RetCam wide-field infant fundus image.
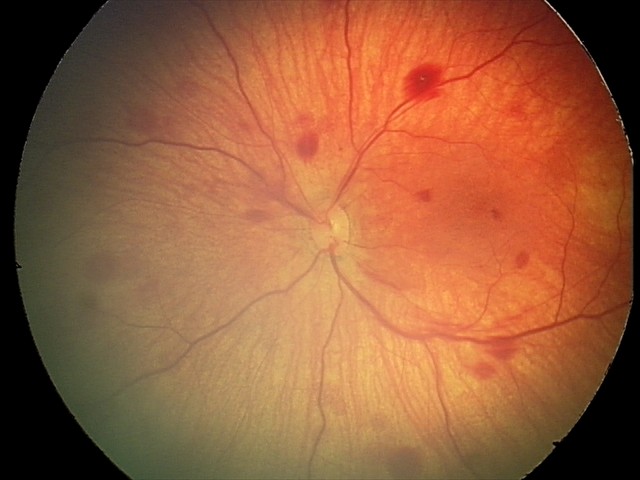

From an examination with diagnosis of retinal hemorrhages.